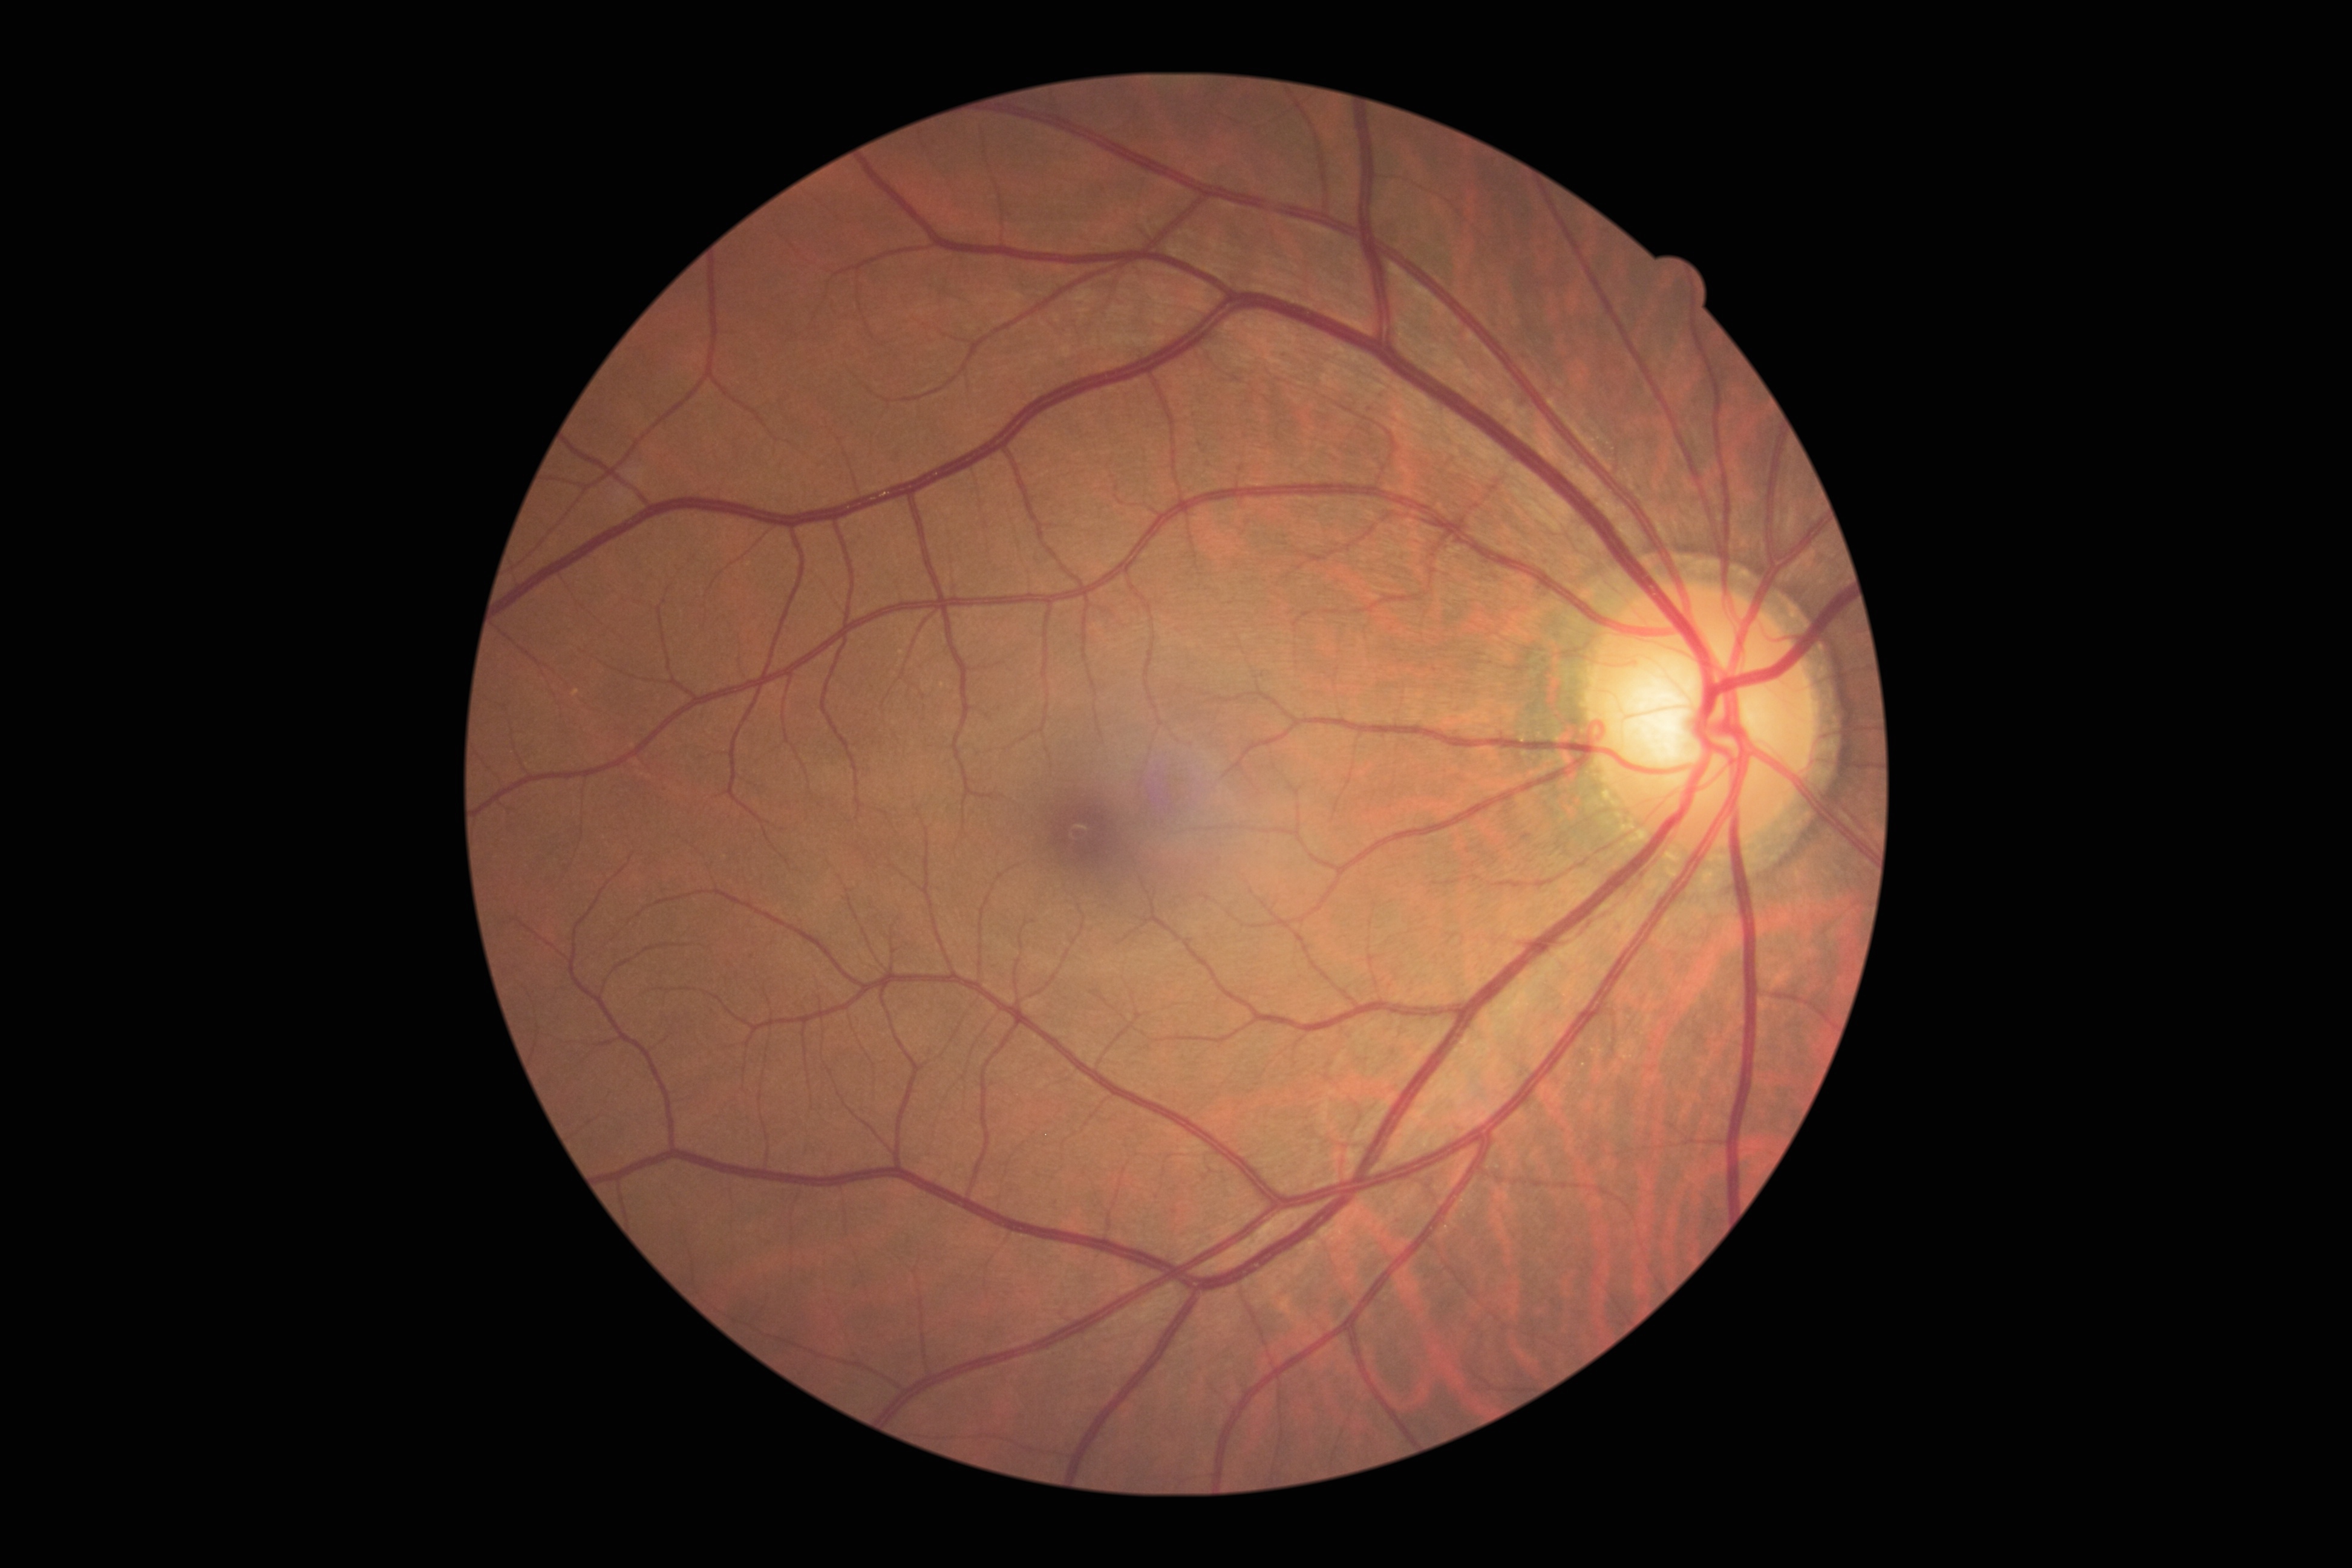
DR grade: 0 (no apparent retinopathy) — no visible signs of diabetic retinopathy.